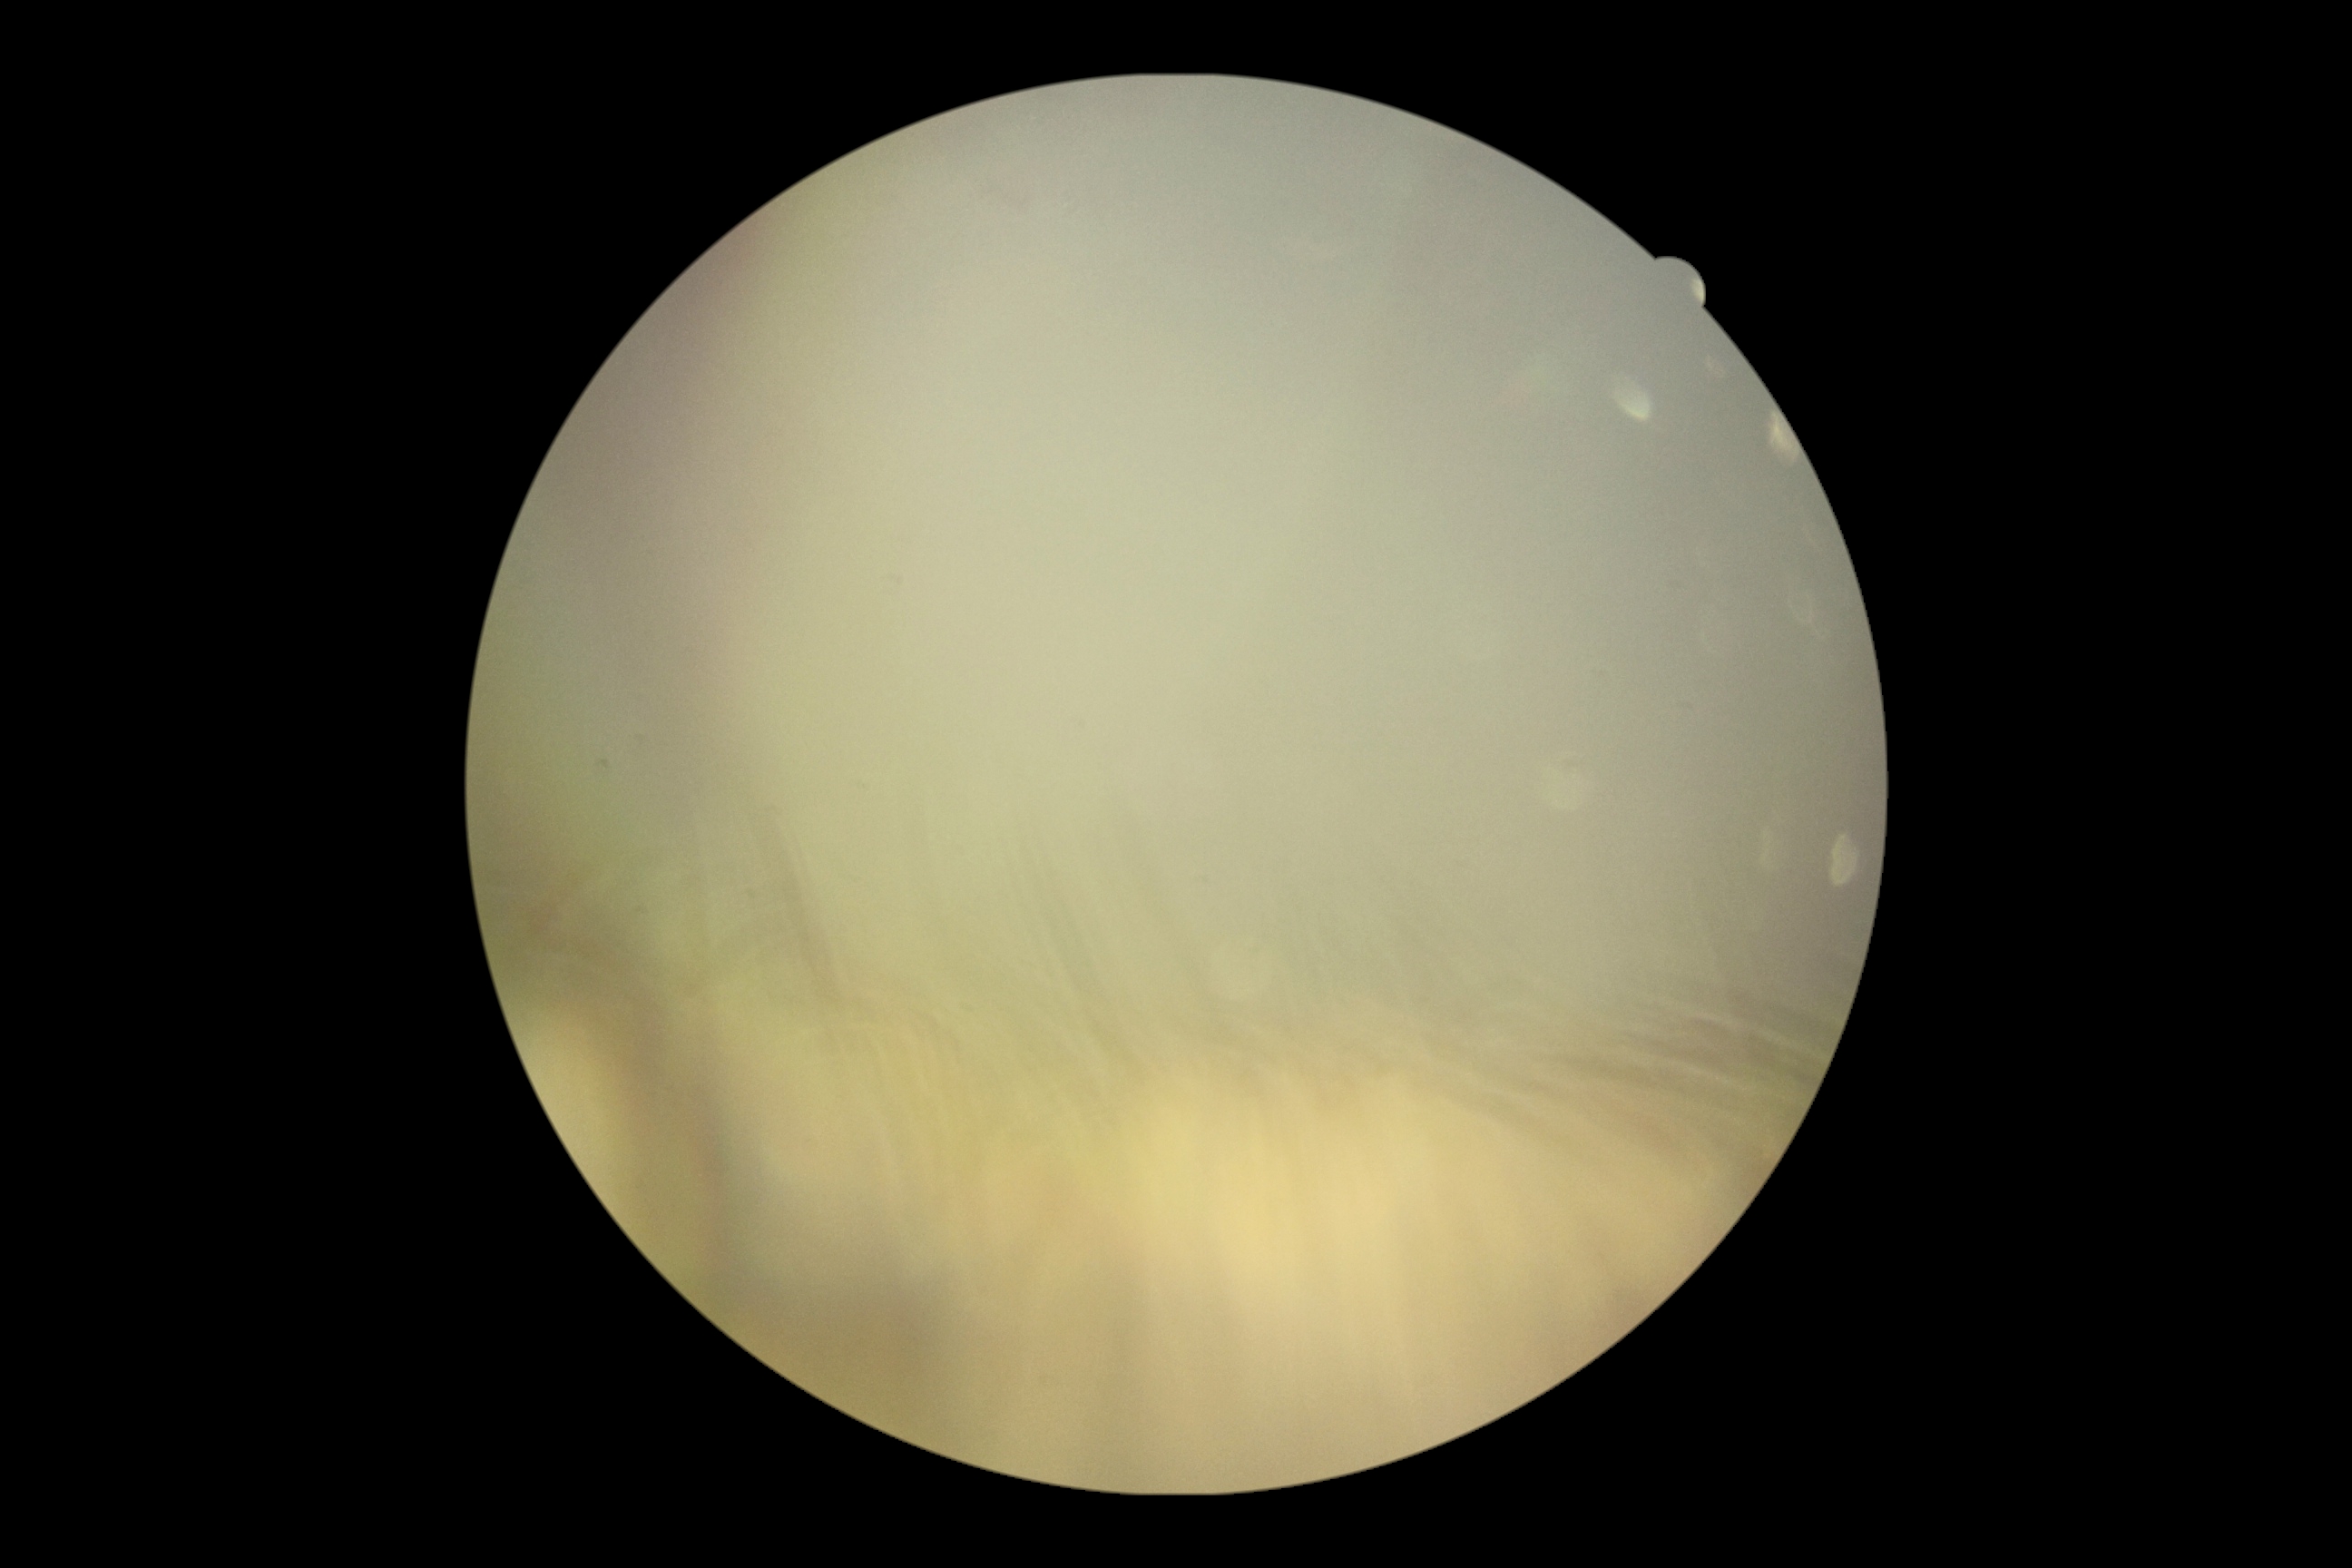 diabetic retinopathy (DR): ungradable.